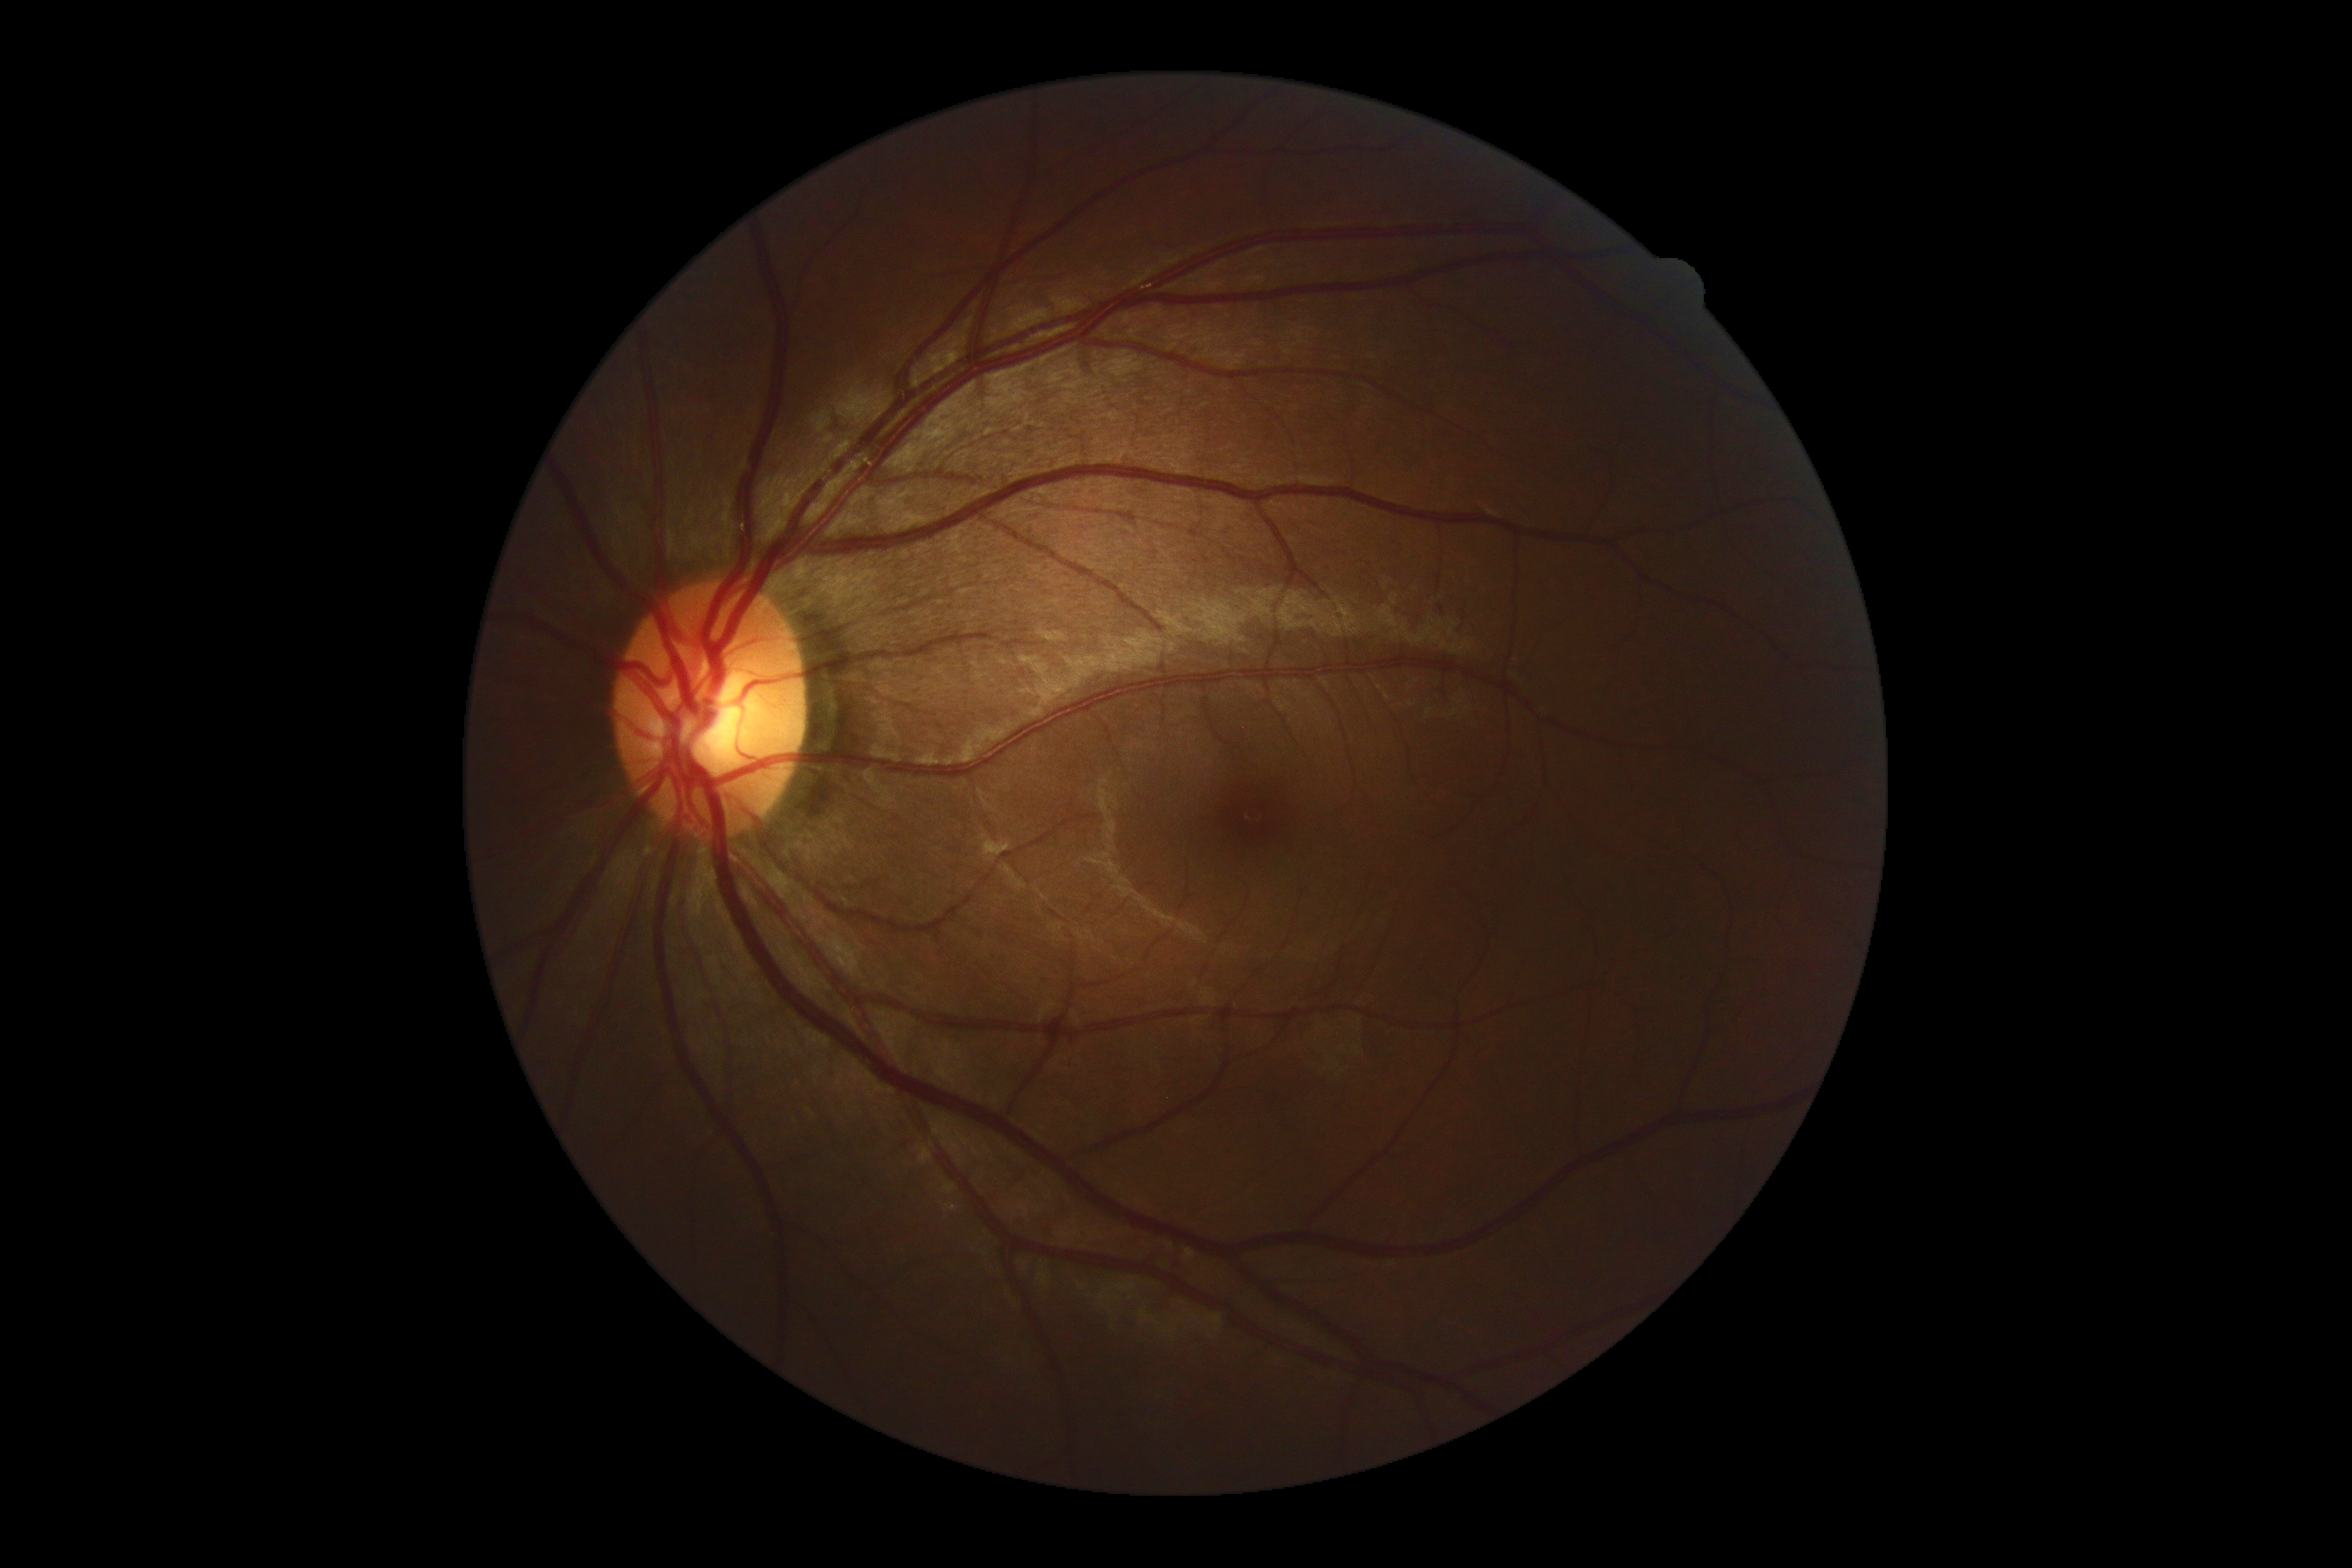
Annotations:
– DR: 0/4